240x240 · retinal fundus photograph.
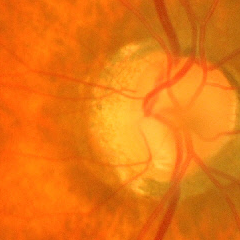

Advanced glaucoma.